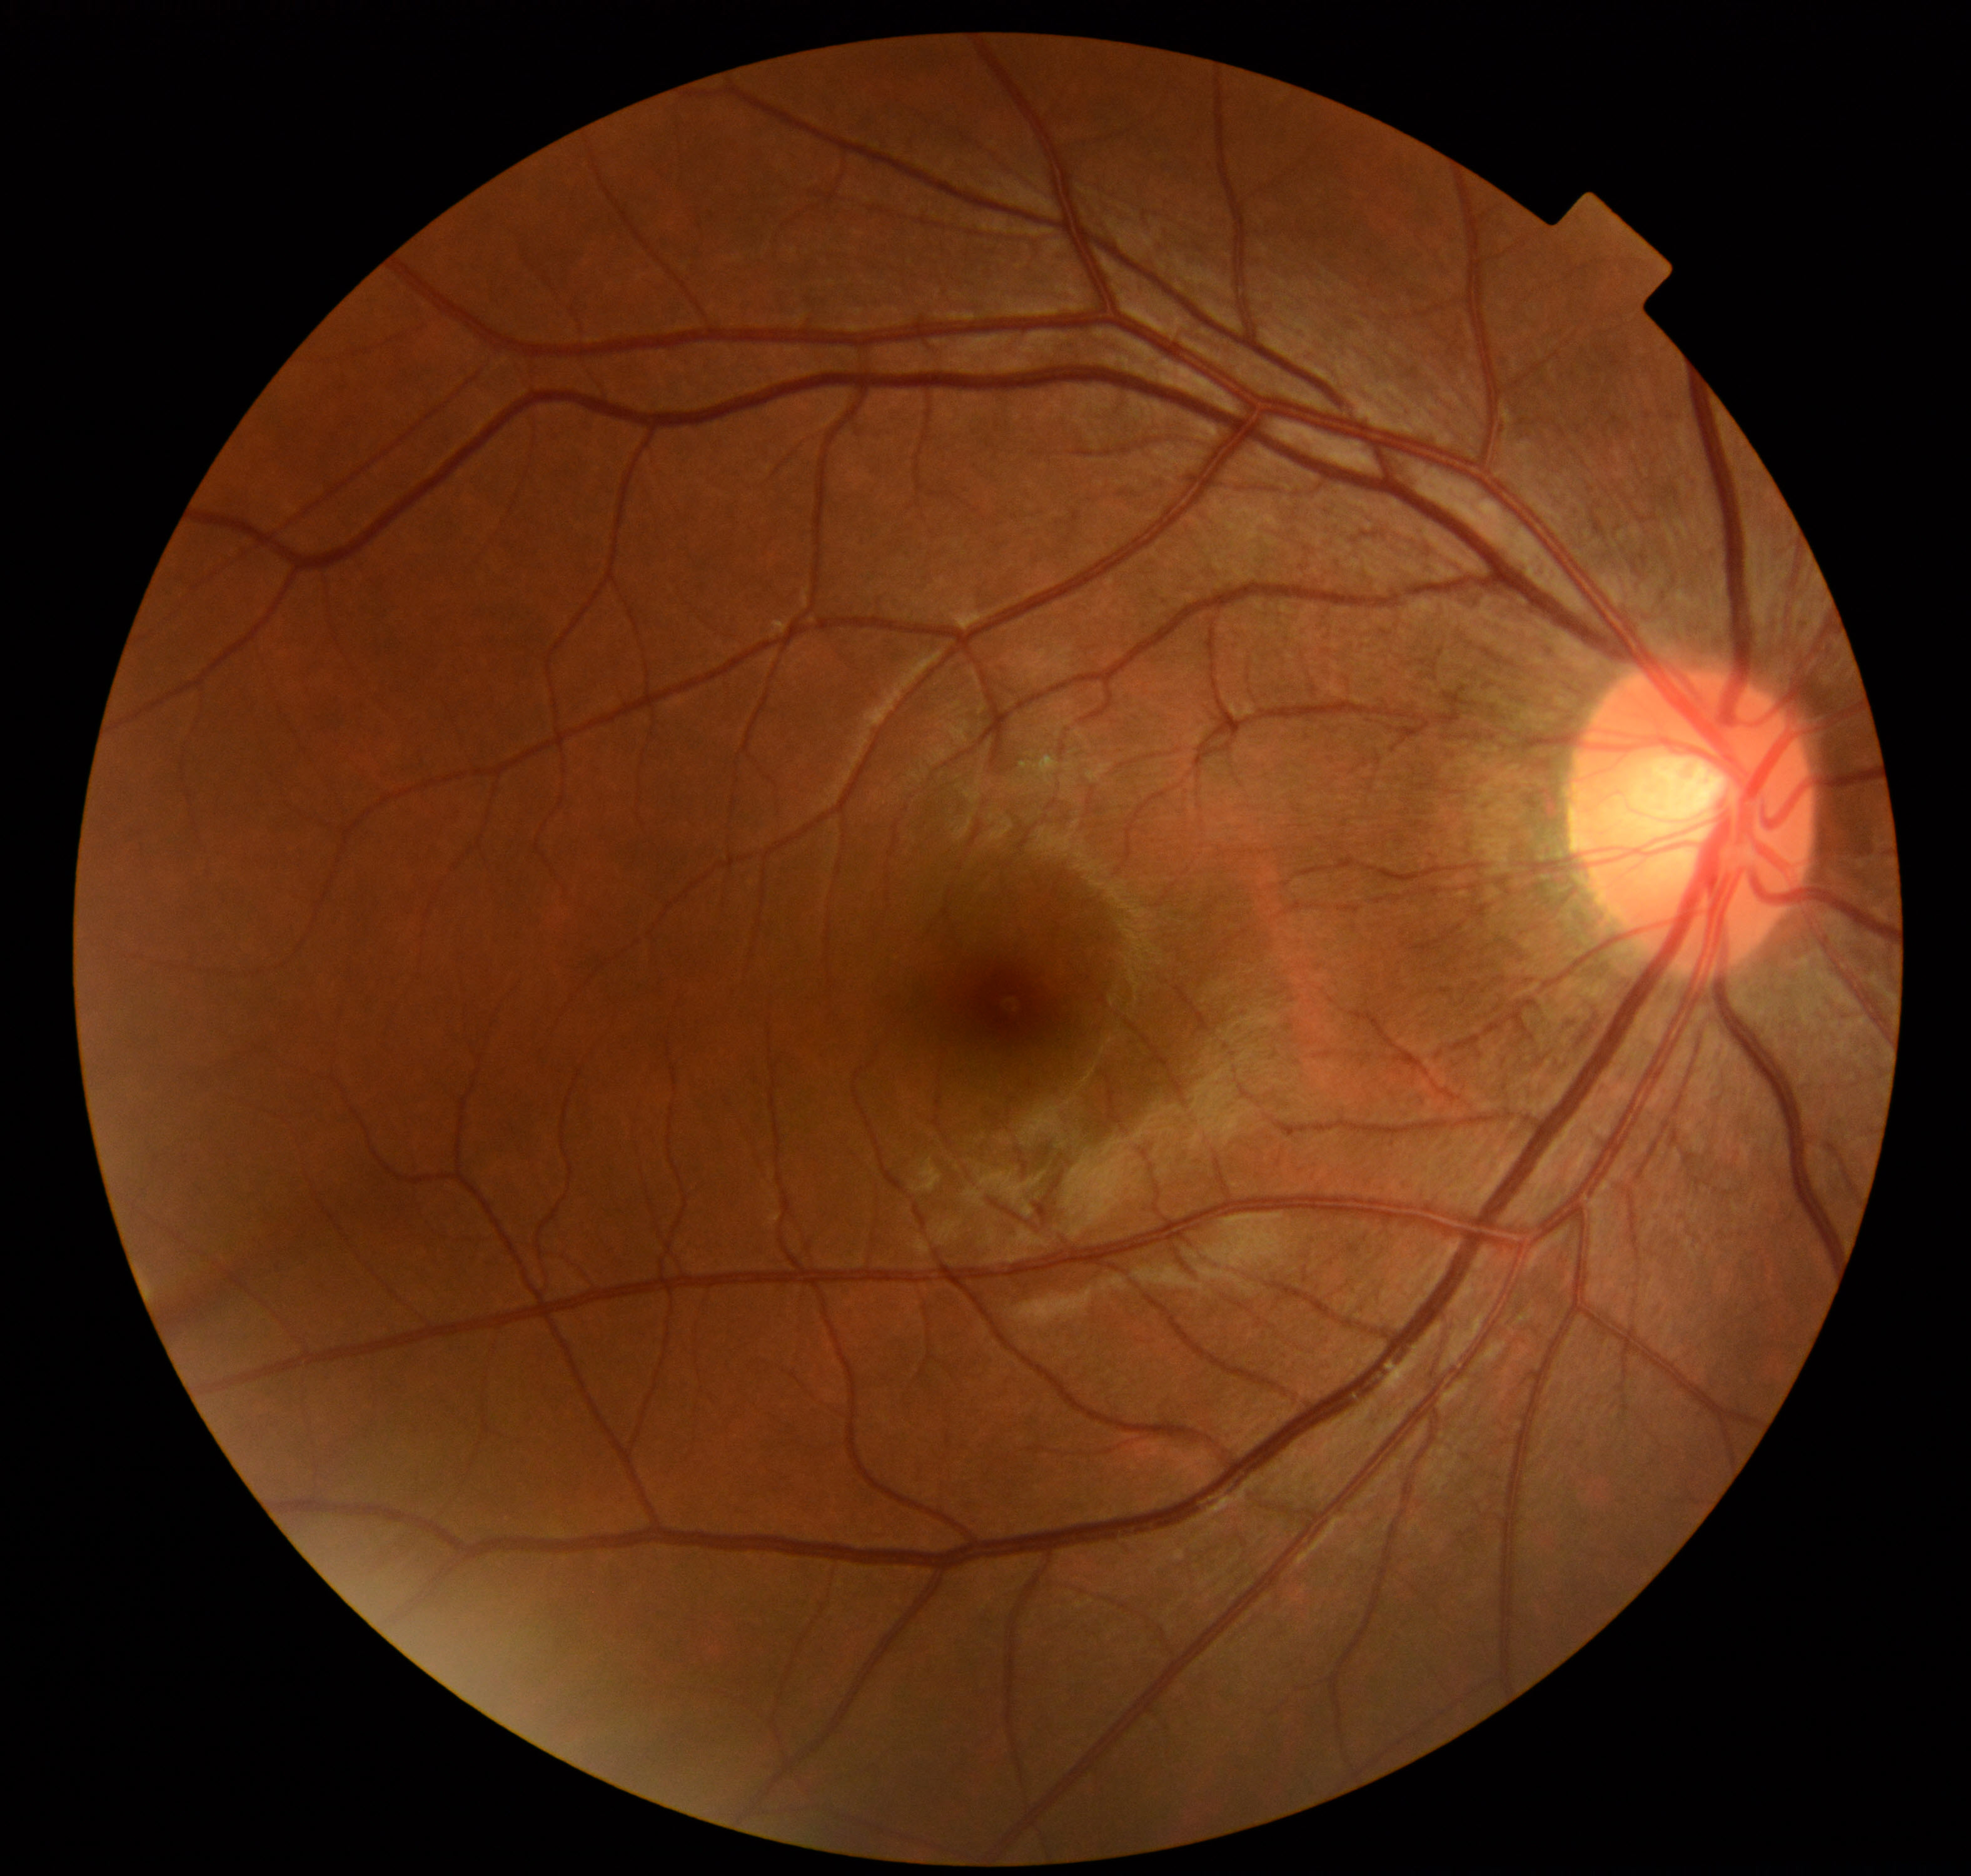 Normal fundus. No pathology identified.